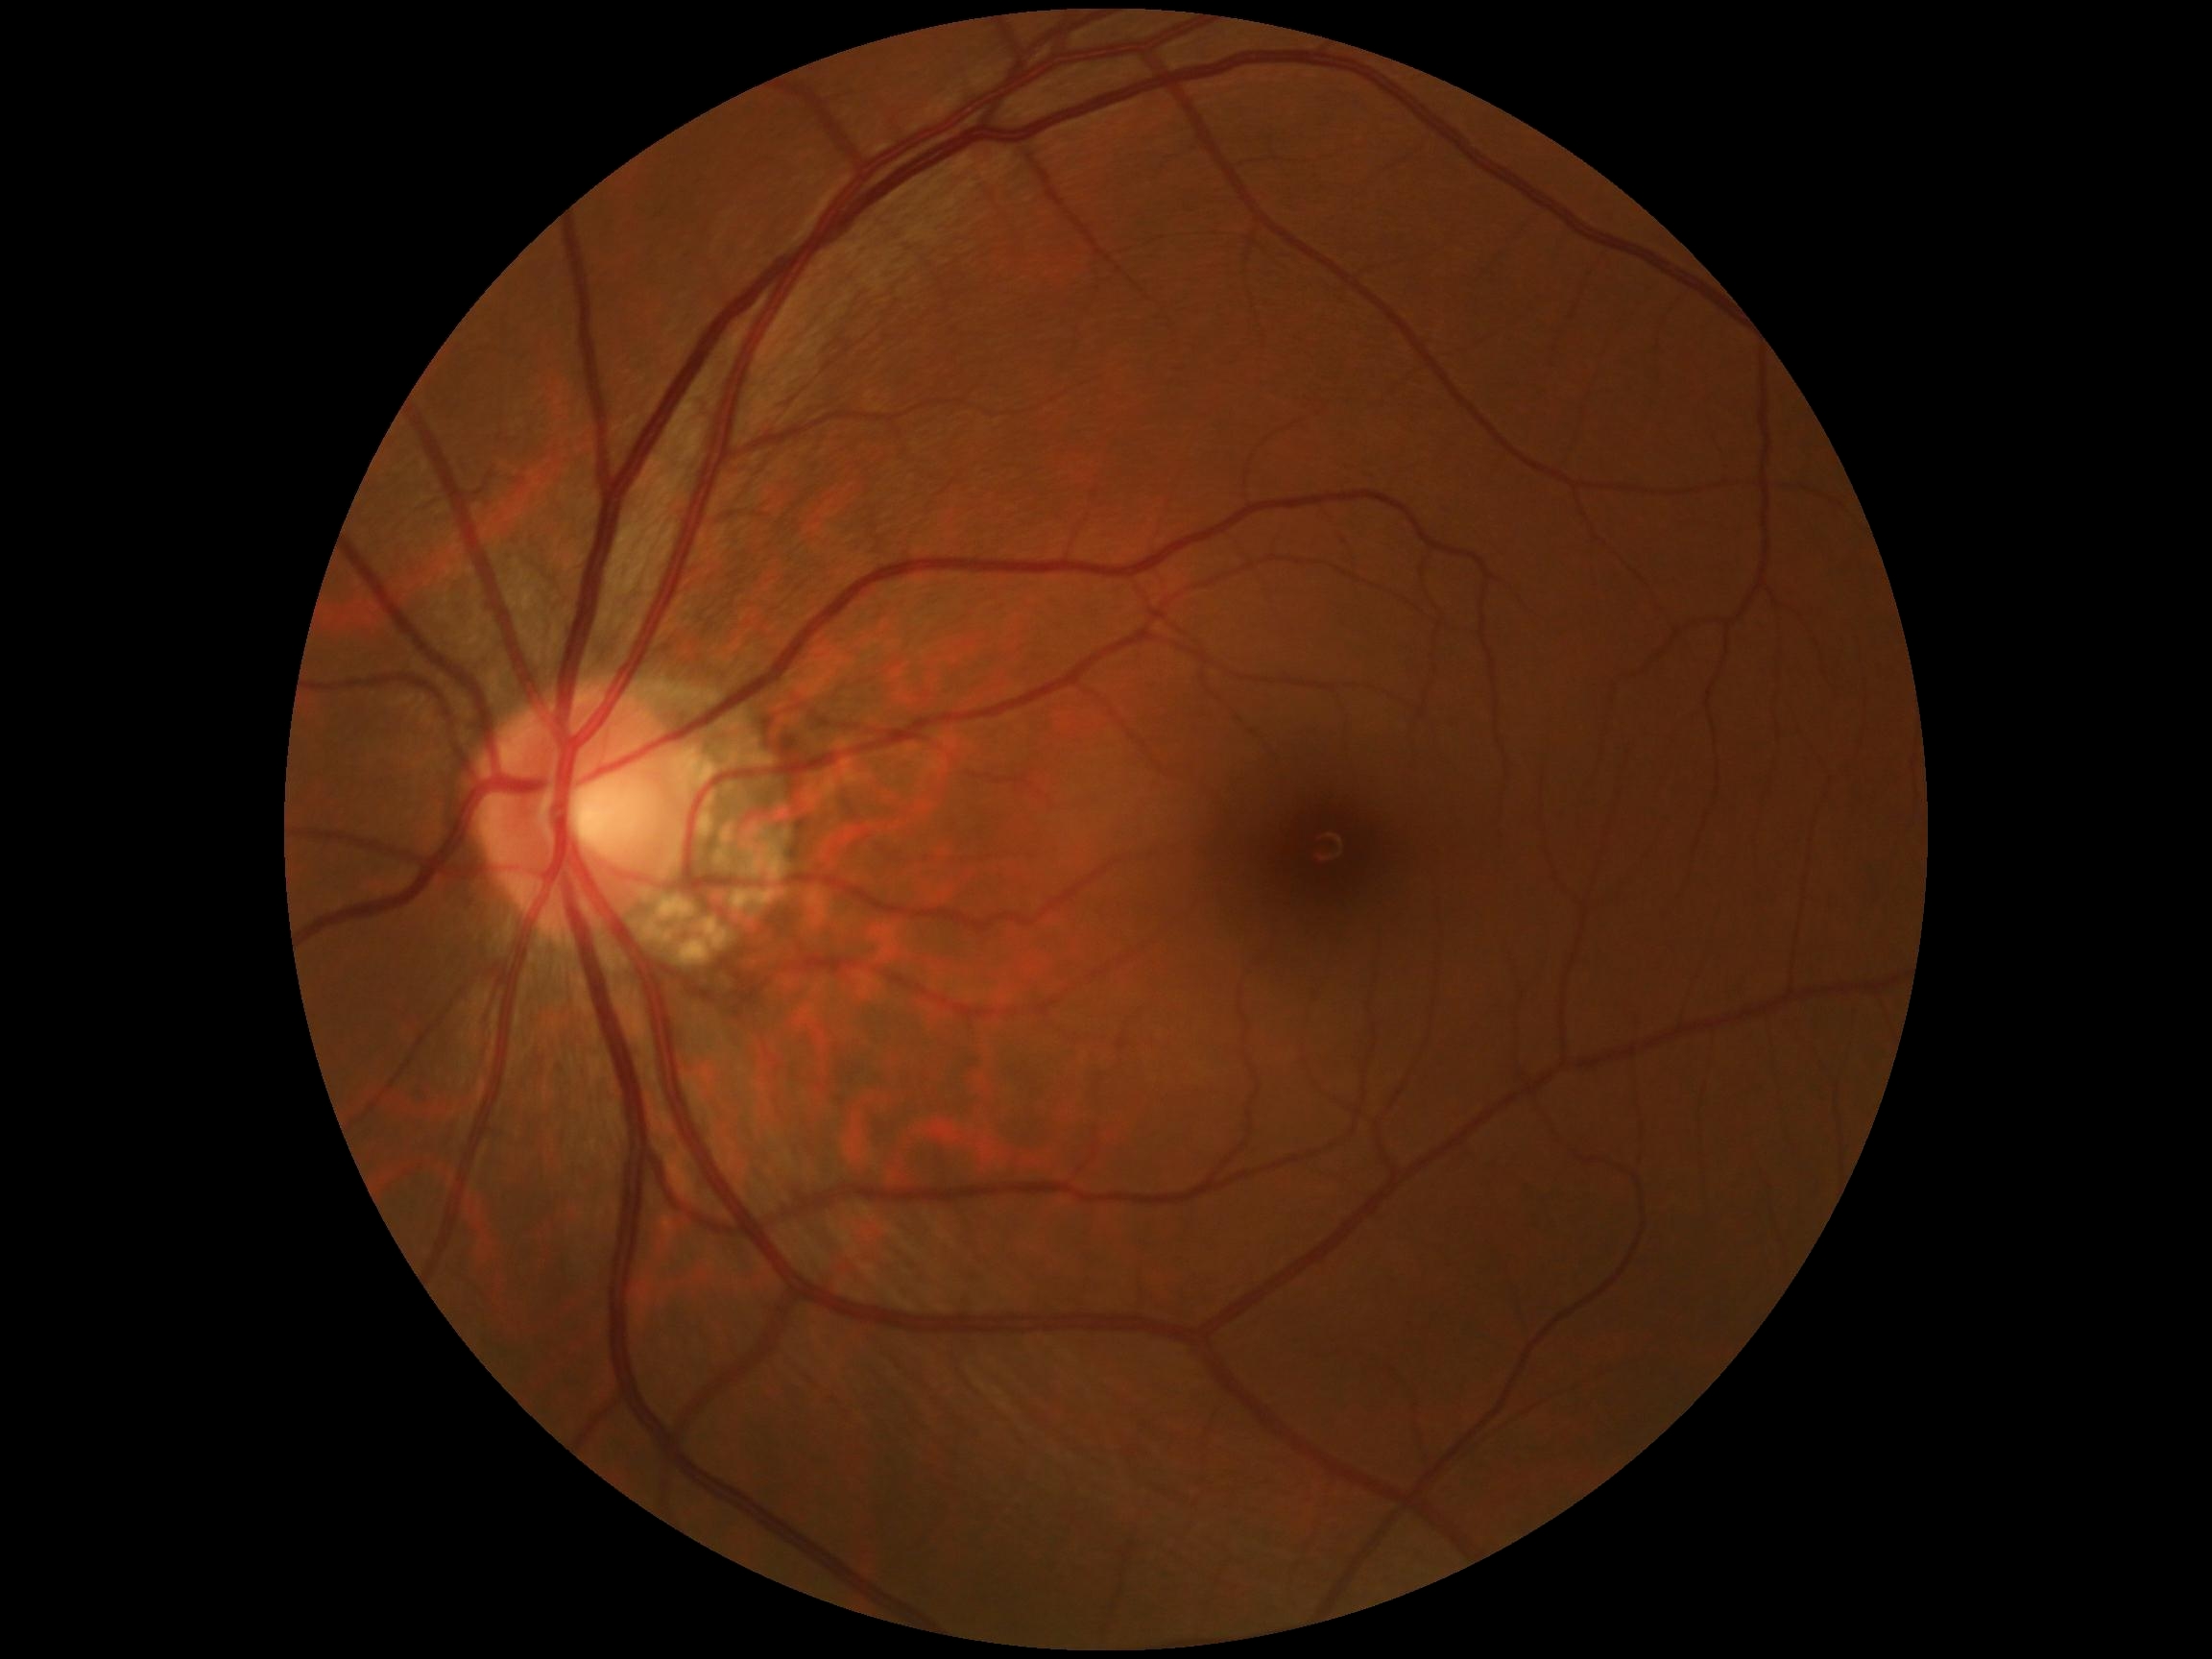
* diabetic retinopathy severity — 0